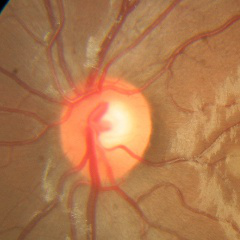 Glaucoma status: no glaucomatous optic neuropathy.